1932x1932 — 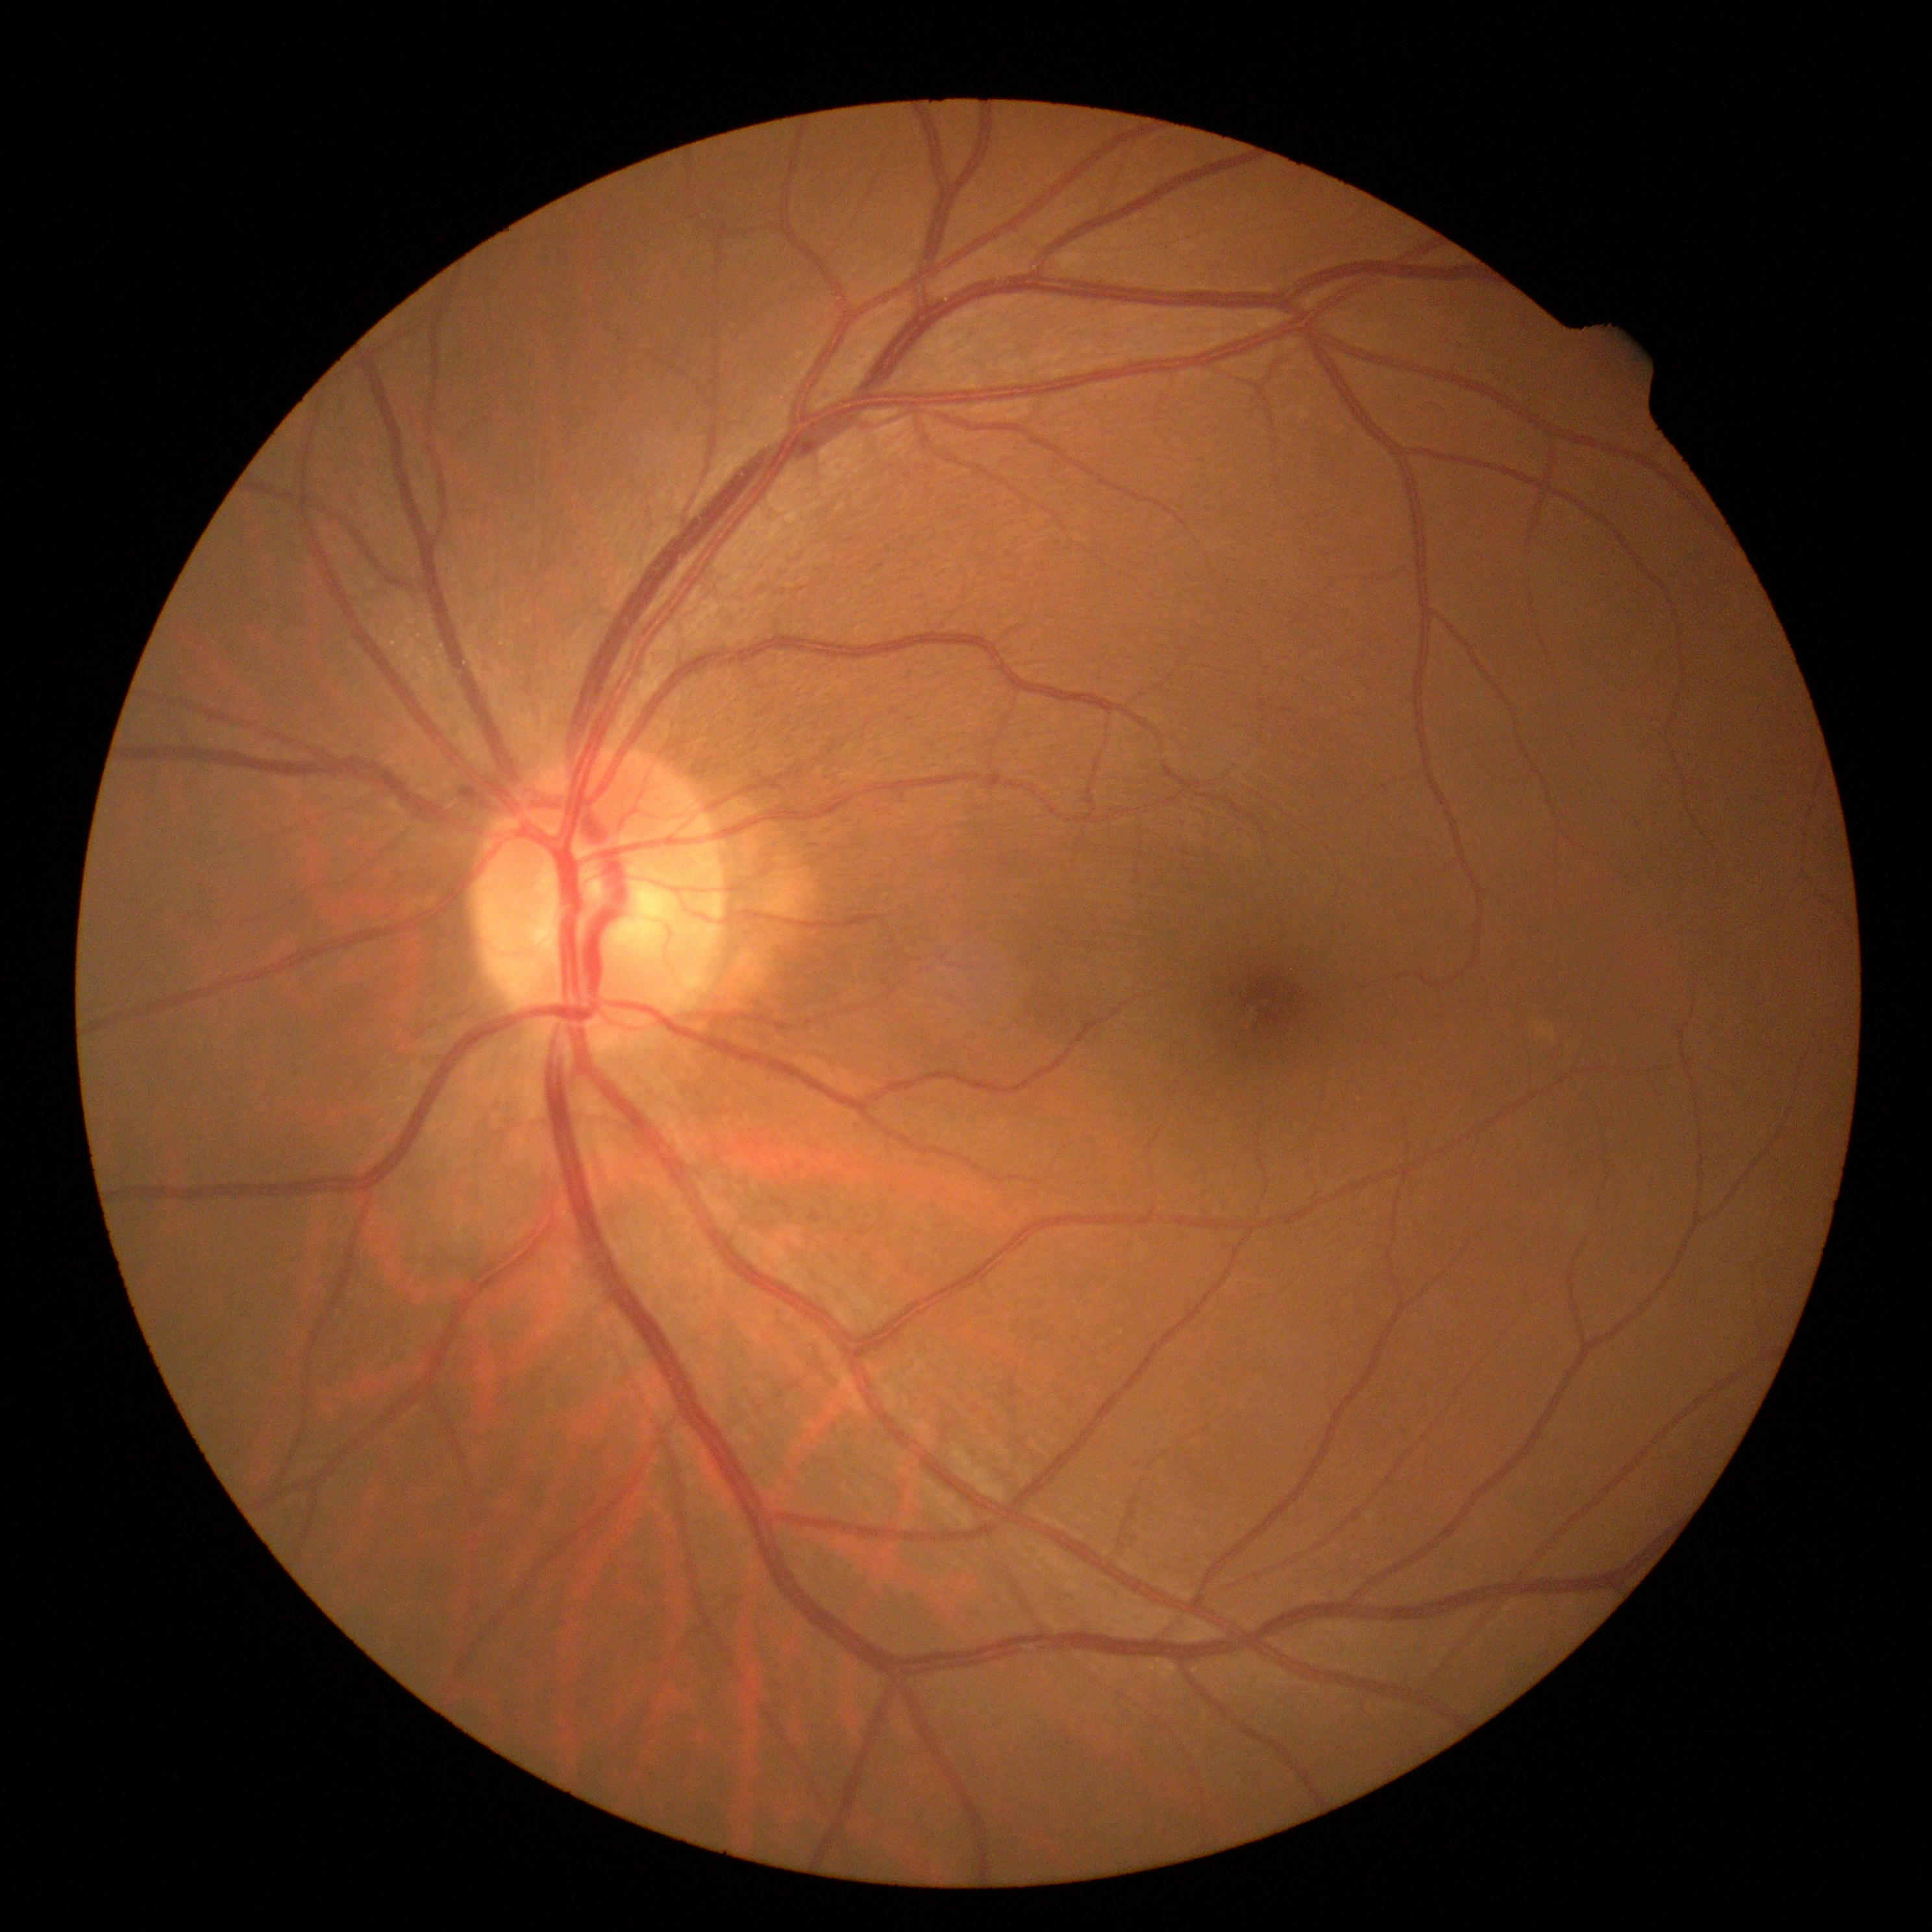 DR severity is no apparent diabetic retinopathy (grade 0).